Ultra-widefield fundus mosaic.
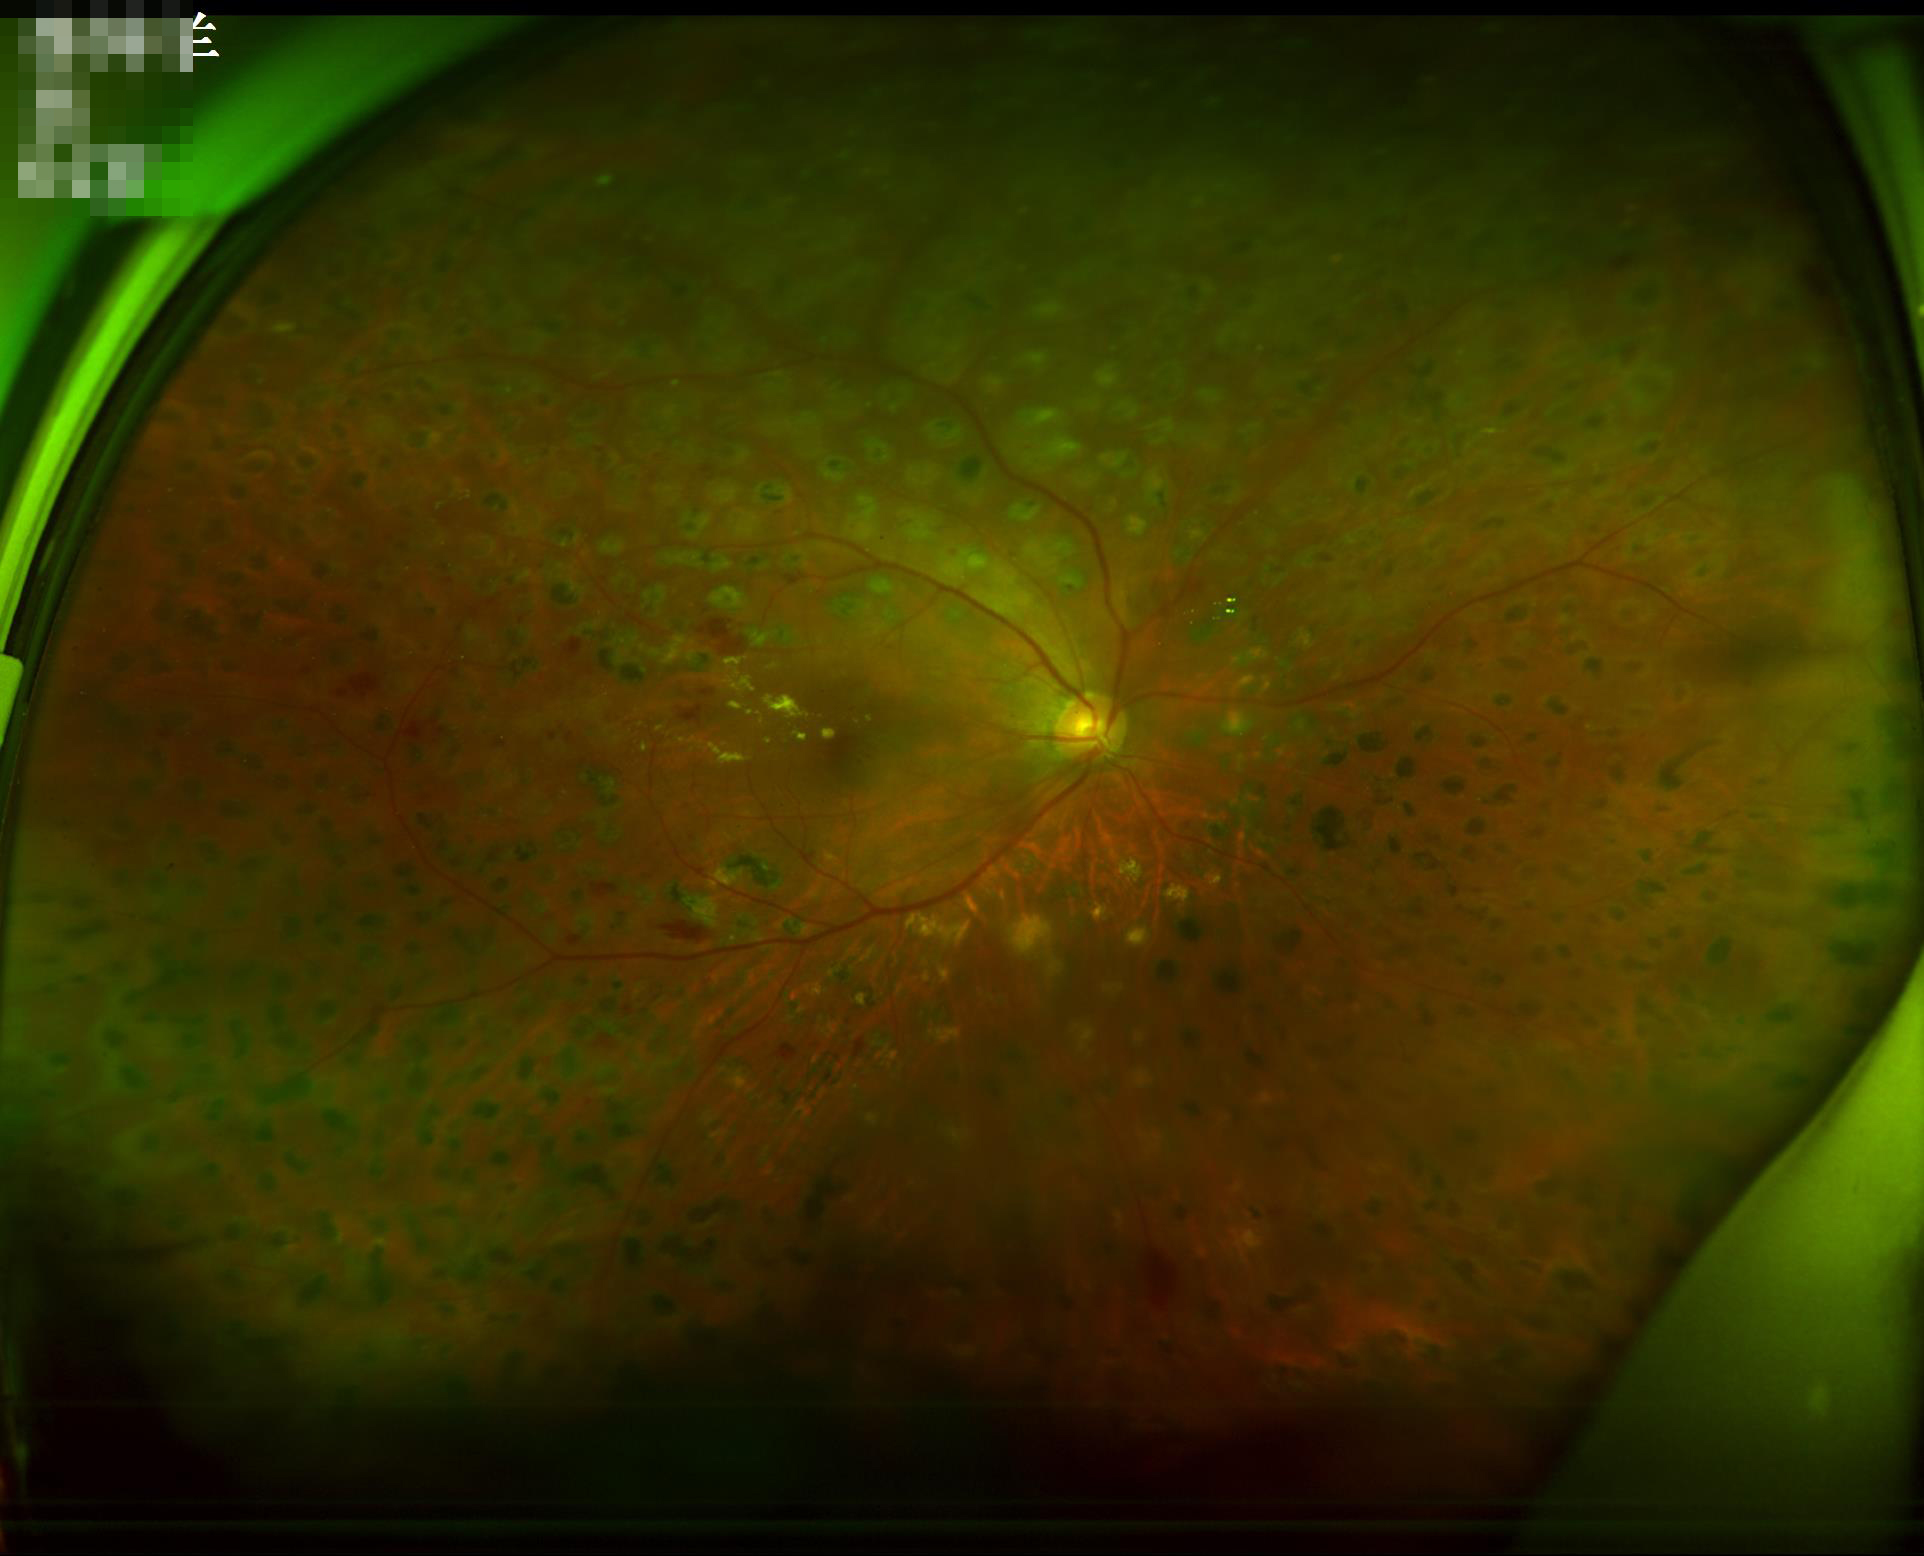
Image quality is adequate for diagnostic use. Adequate contrast for distinguishing structures. No noticeable blur. No over- or under-exposure.